Image size 1470x1137
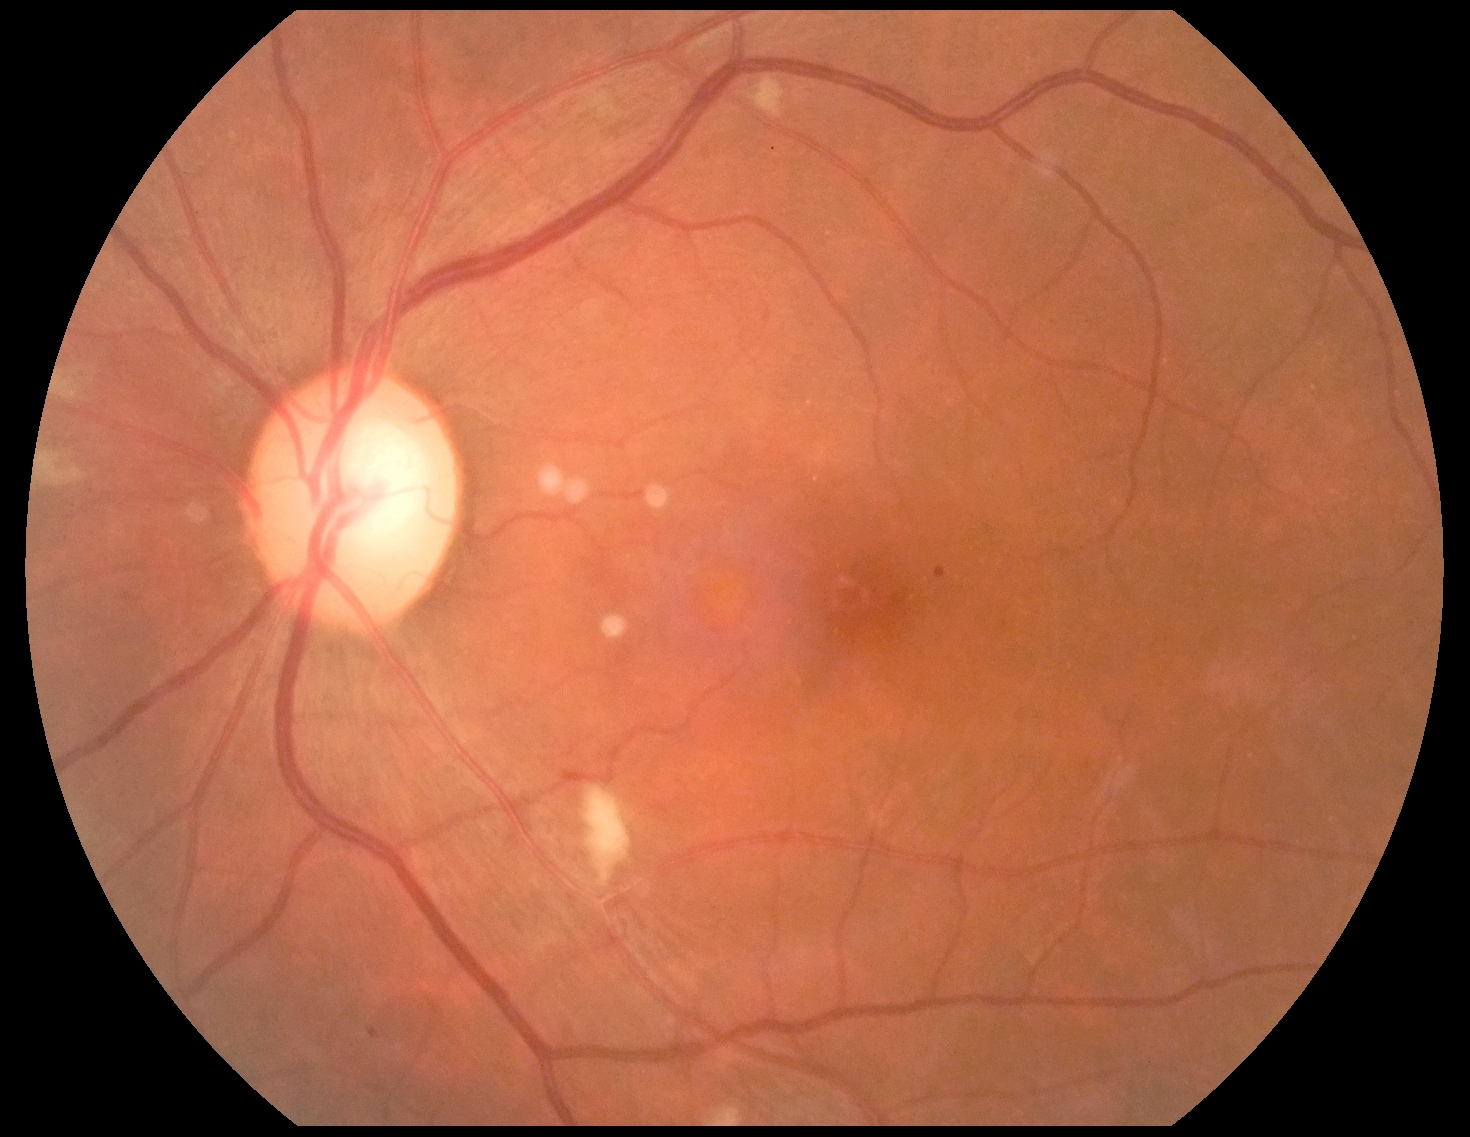

  dr_grade: grade 2